2048 by 1536 pixels. Color fundus image. 45-degree field of view
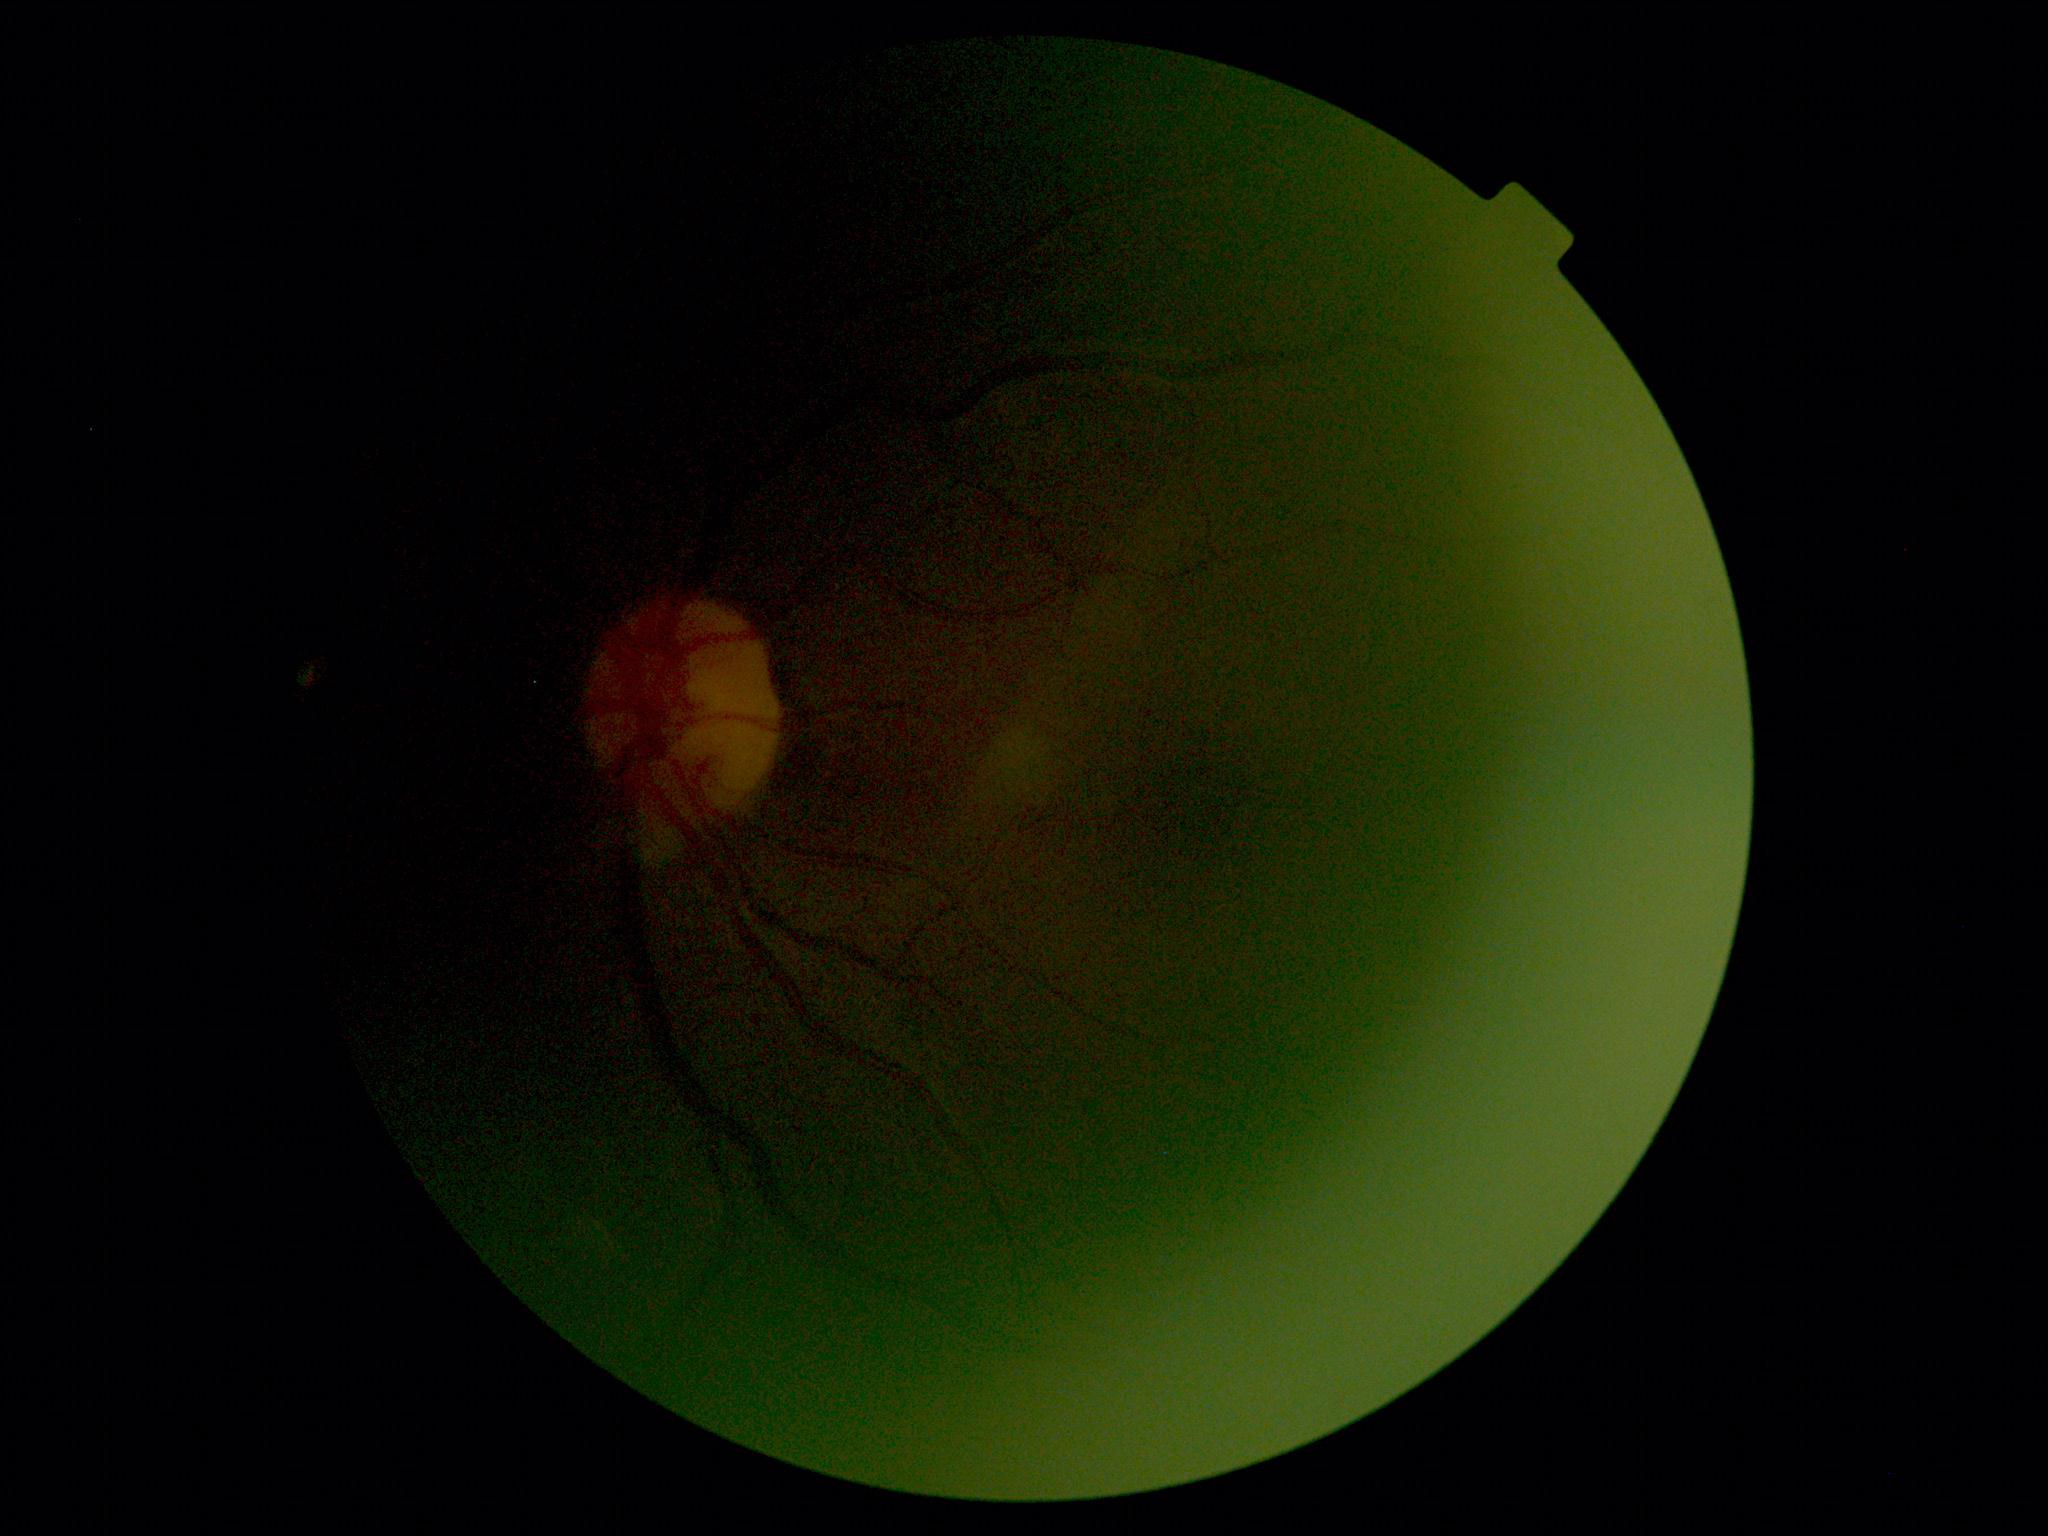 DR grade=ungradable, image quality=insufficient for DR assessment.